Camera: Clarity RetCam 3 (130° FOV); pediatric wide-field fundus photograph
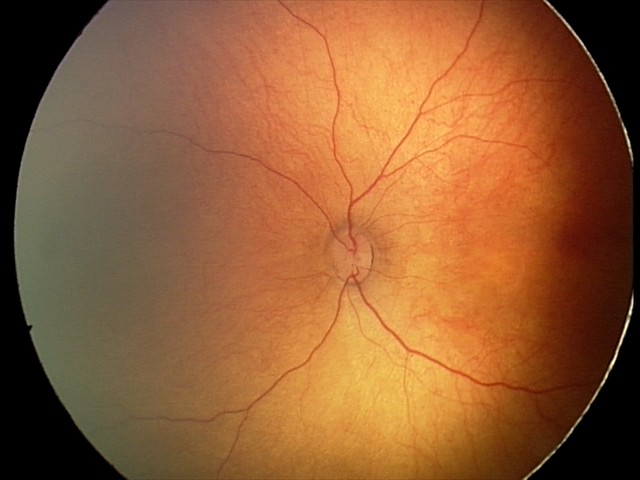

Screening diagnosis: no abnormal retinal findings.